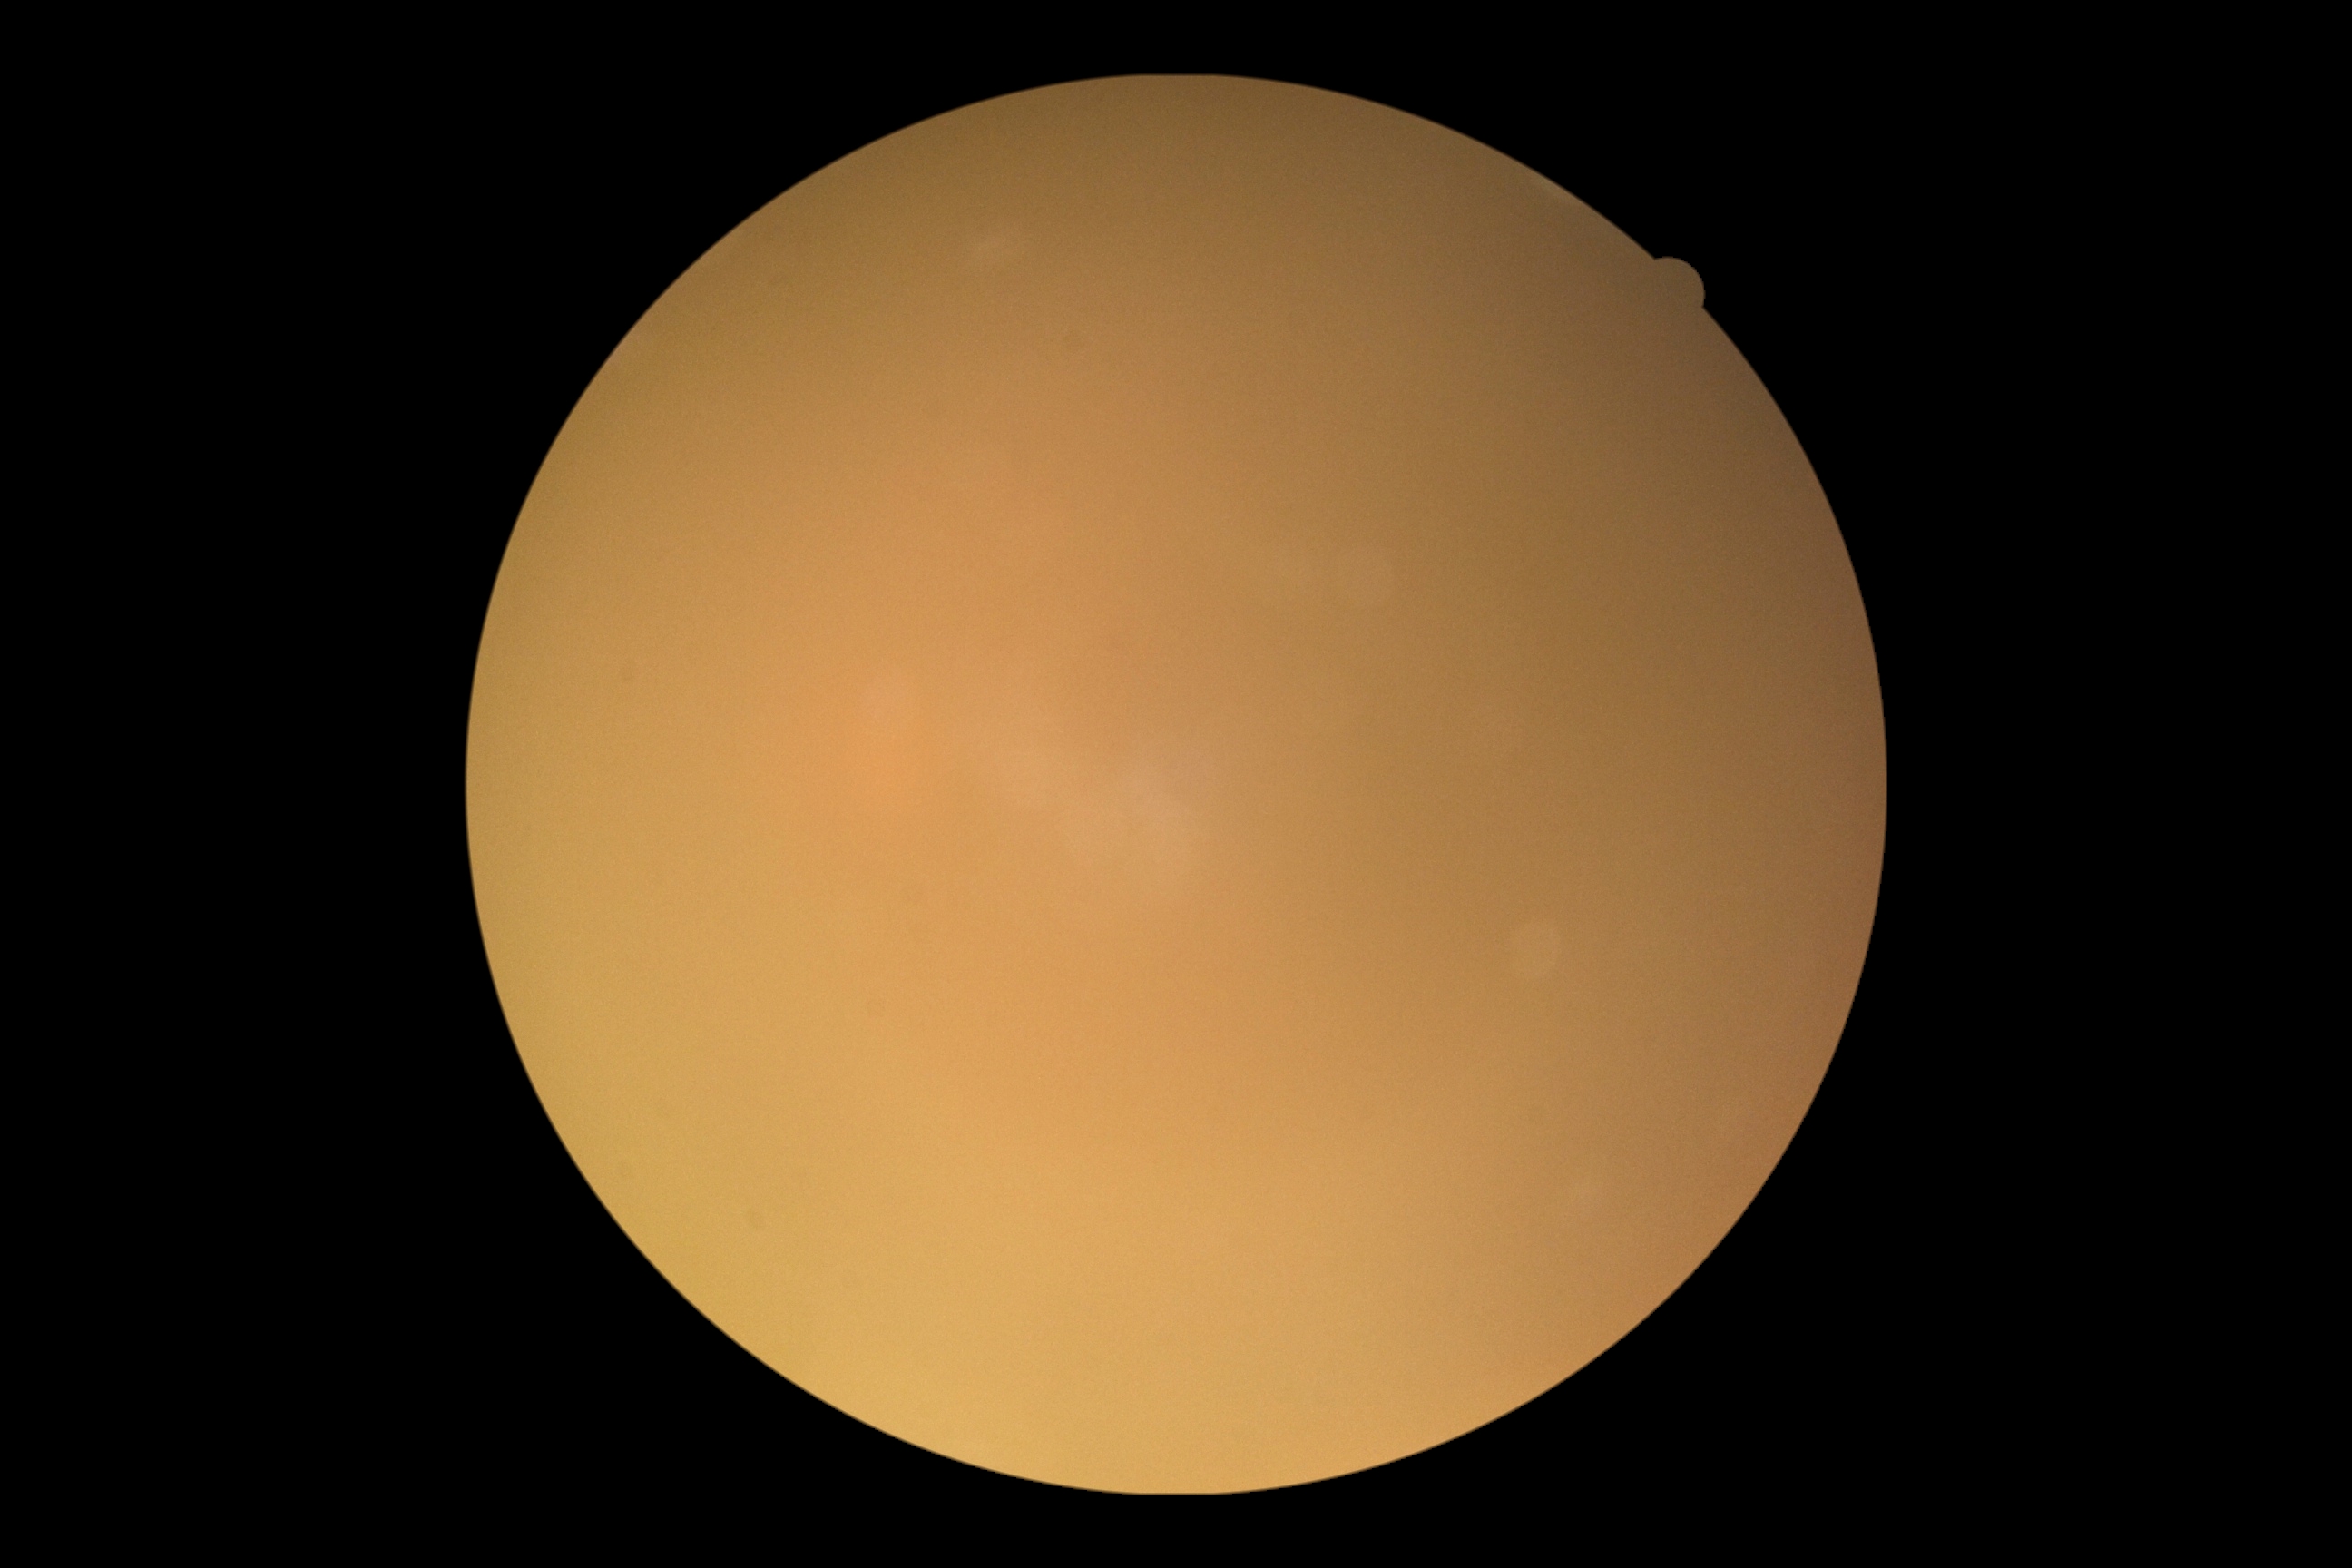

DR grade: ungradable due to poor image quality; image quality: too poor for DR grading.